Nonmydriatic; Davis DR grading.
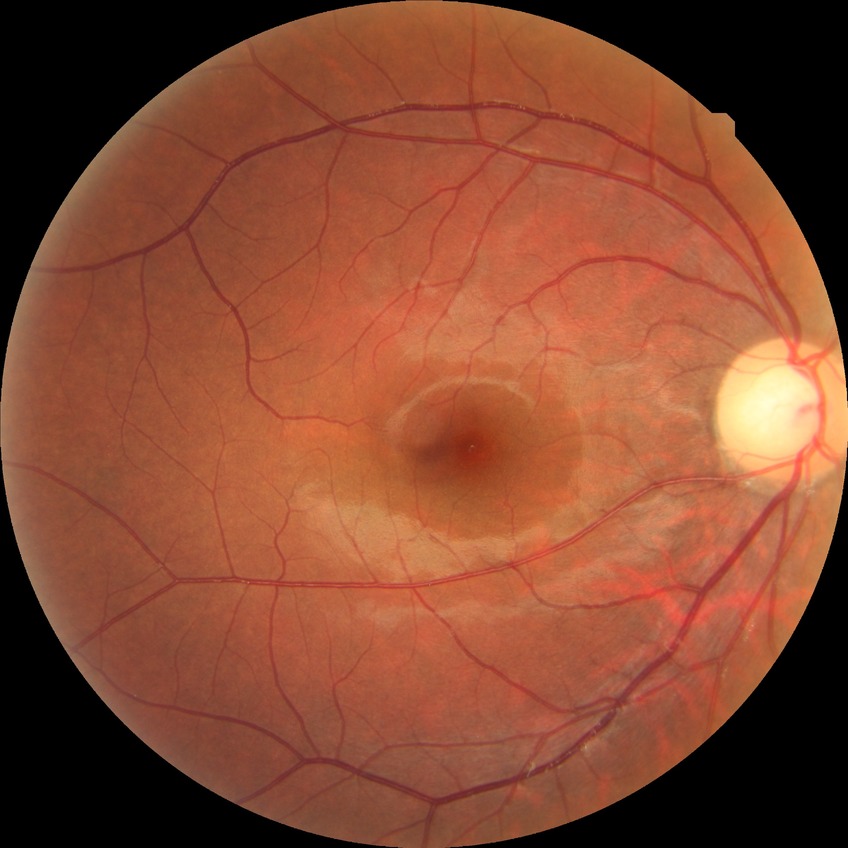

diabetic retinopathy (DR)=no diabetic retinopathy (NDR).